240 by 240 pixels. Color fundus photograph. Captured without pupil dilation.
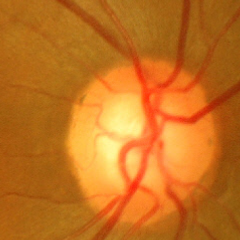
Optic disc appearance consistent with no glaucomatous findings.